45-degree field of view: 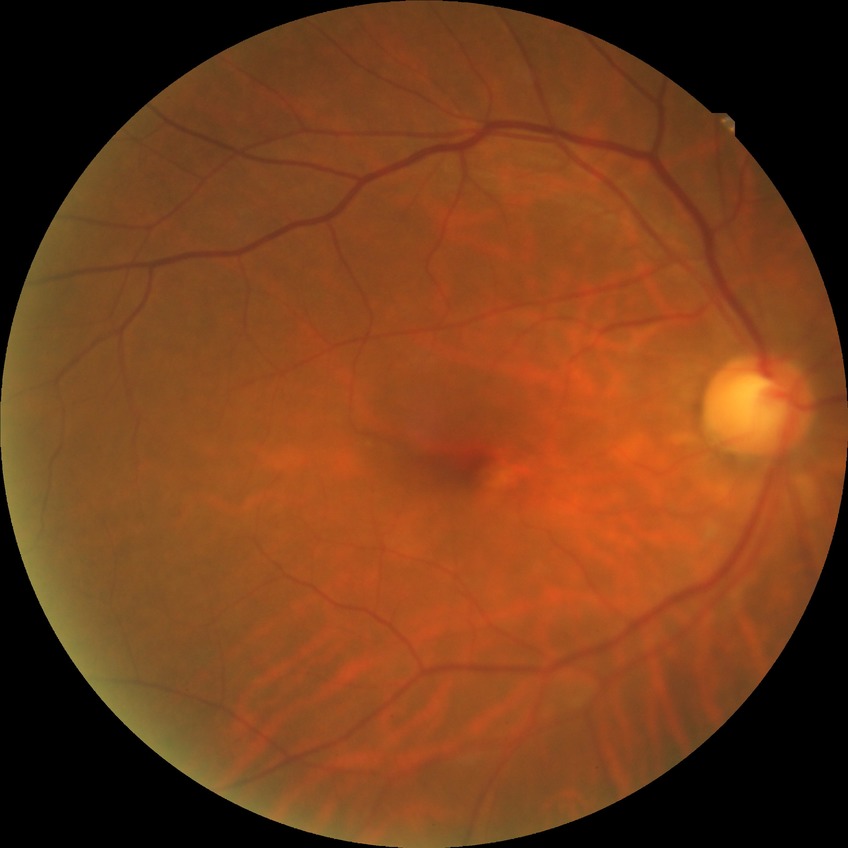

Diabetic retinopathy (DR): no diabetic retinopathy (NDR).